2346 by 1568 pixels — 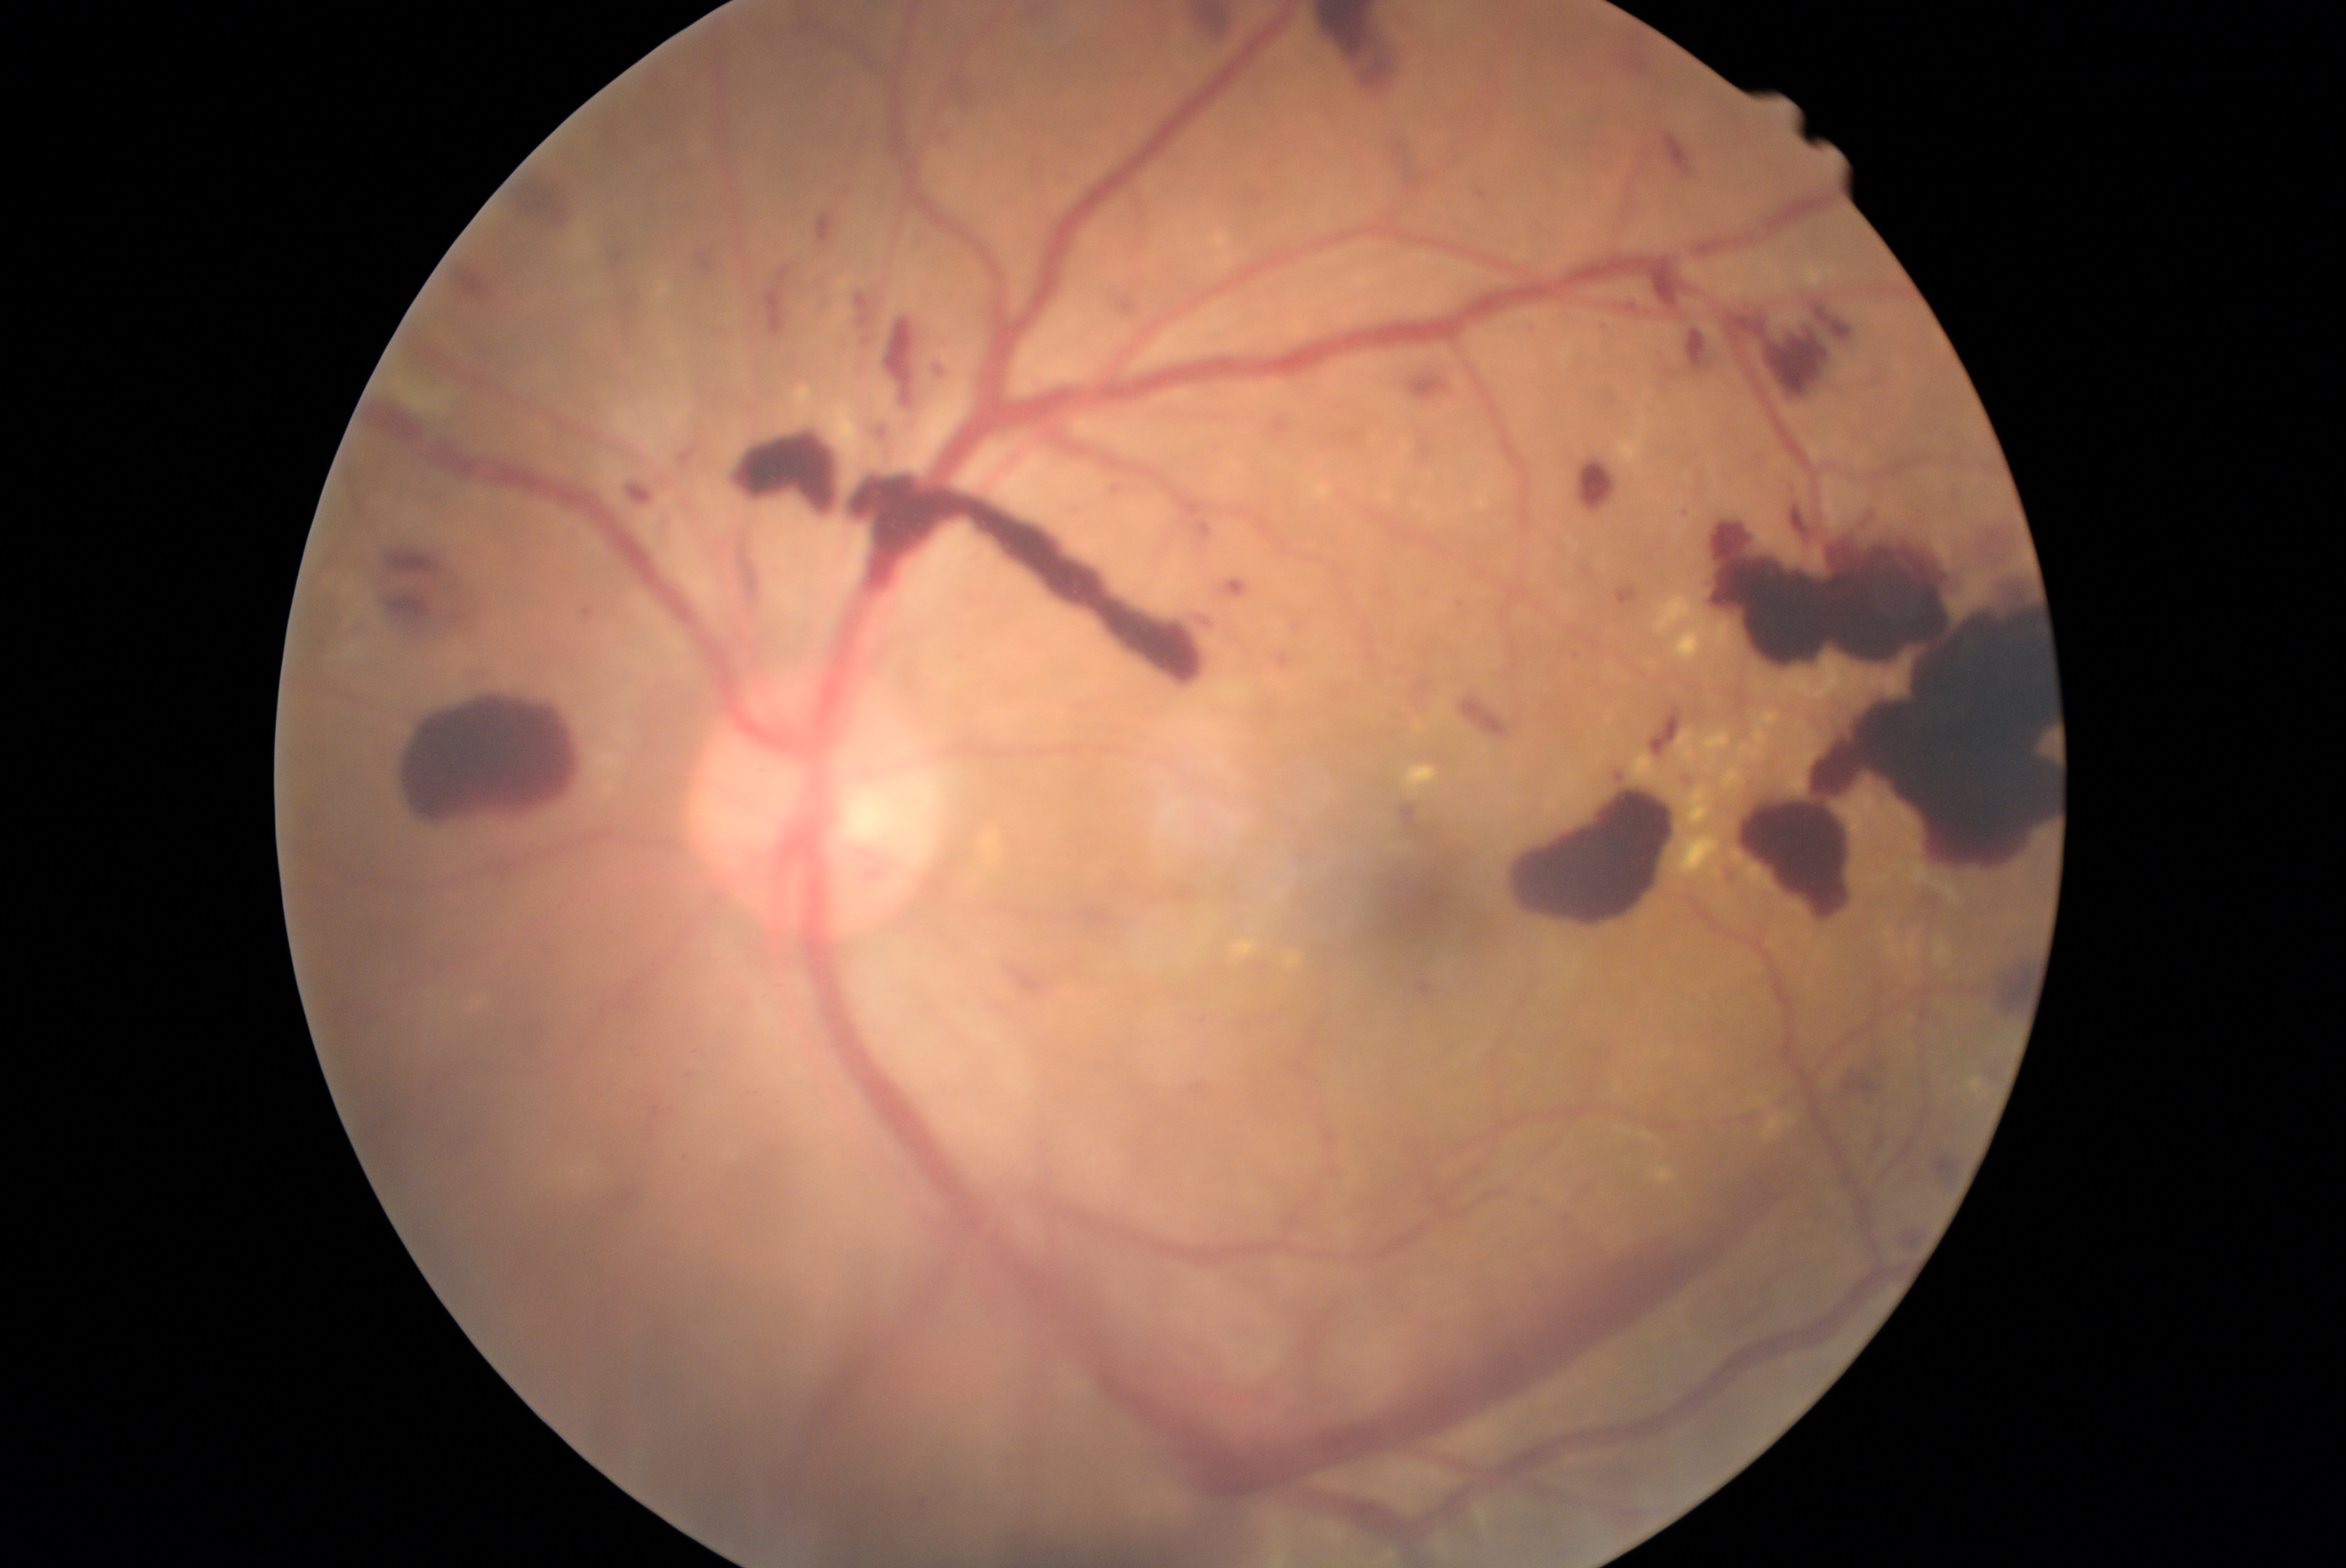
Diabetic retinopathy (DR) is grade 4 (PDR)
Selected lesions:
• hemorrhages (HEs) (continued): 1414 366 1462 410; 906 230 939 266; 1105 479 1138 503; 1288 623 1309 637; 1411 662 1436 717; 859 336 876 350; 1723 865 1741 891; 631 485 652 503; 1199 524 1210 537; 1042 1053 1887 1497; 1991 953 2036 1015; 882 316 920 408; 462 658 504 684; 1310 13 1404 96; 1649 264 1682 314; 1677 772 1698 796; 407 691 579 833; 573 606 598 631; 1611 584 1646 611
• hard exudates (EXs) (continued): 1233 940 1260 960; 984 833 1000 862; 1762 711 1782 727; 1630 753 1663 783; 1655 575 1741 664; 1404 764 1437 793; 1649 1166 1677 1185; 470 1000 488 1014; 1687 786 1715 830; 1644 1131 1652 1139; 1756 1098 1771 1108
• soft exudates (SEs): 394 382 456 418
• microaneurysms (MAs): none